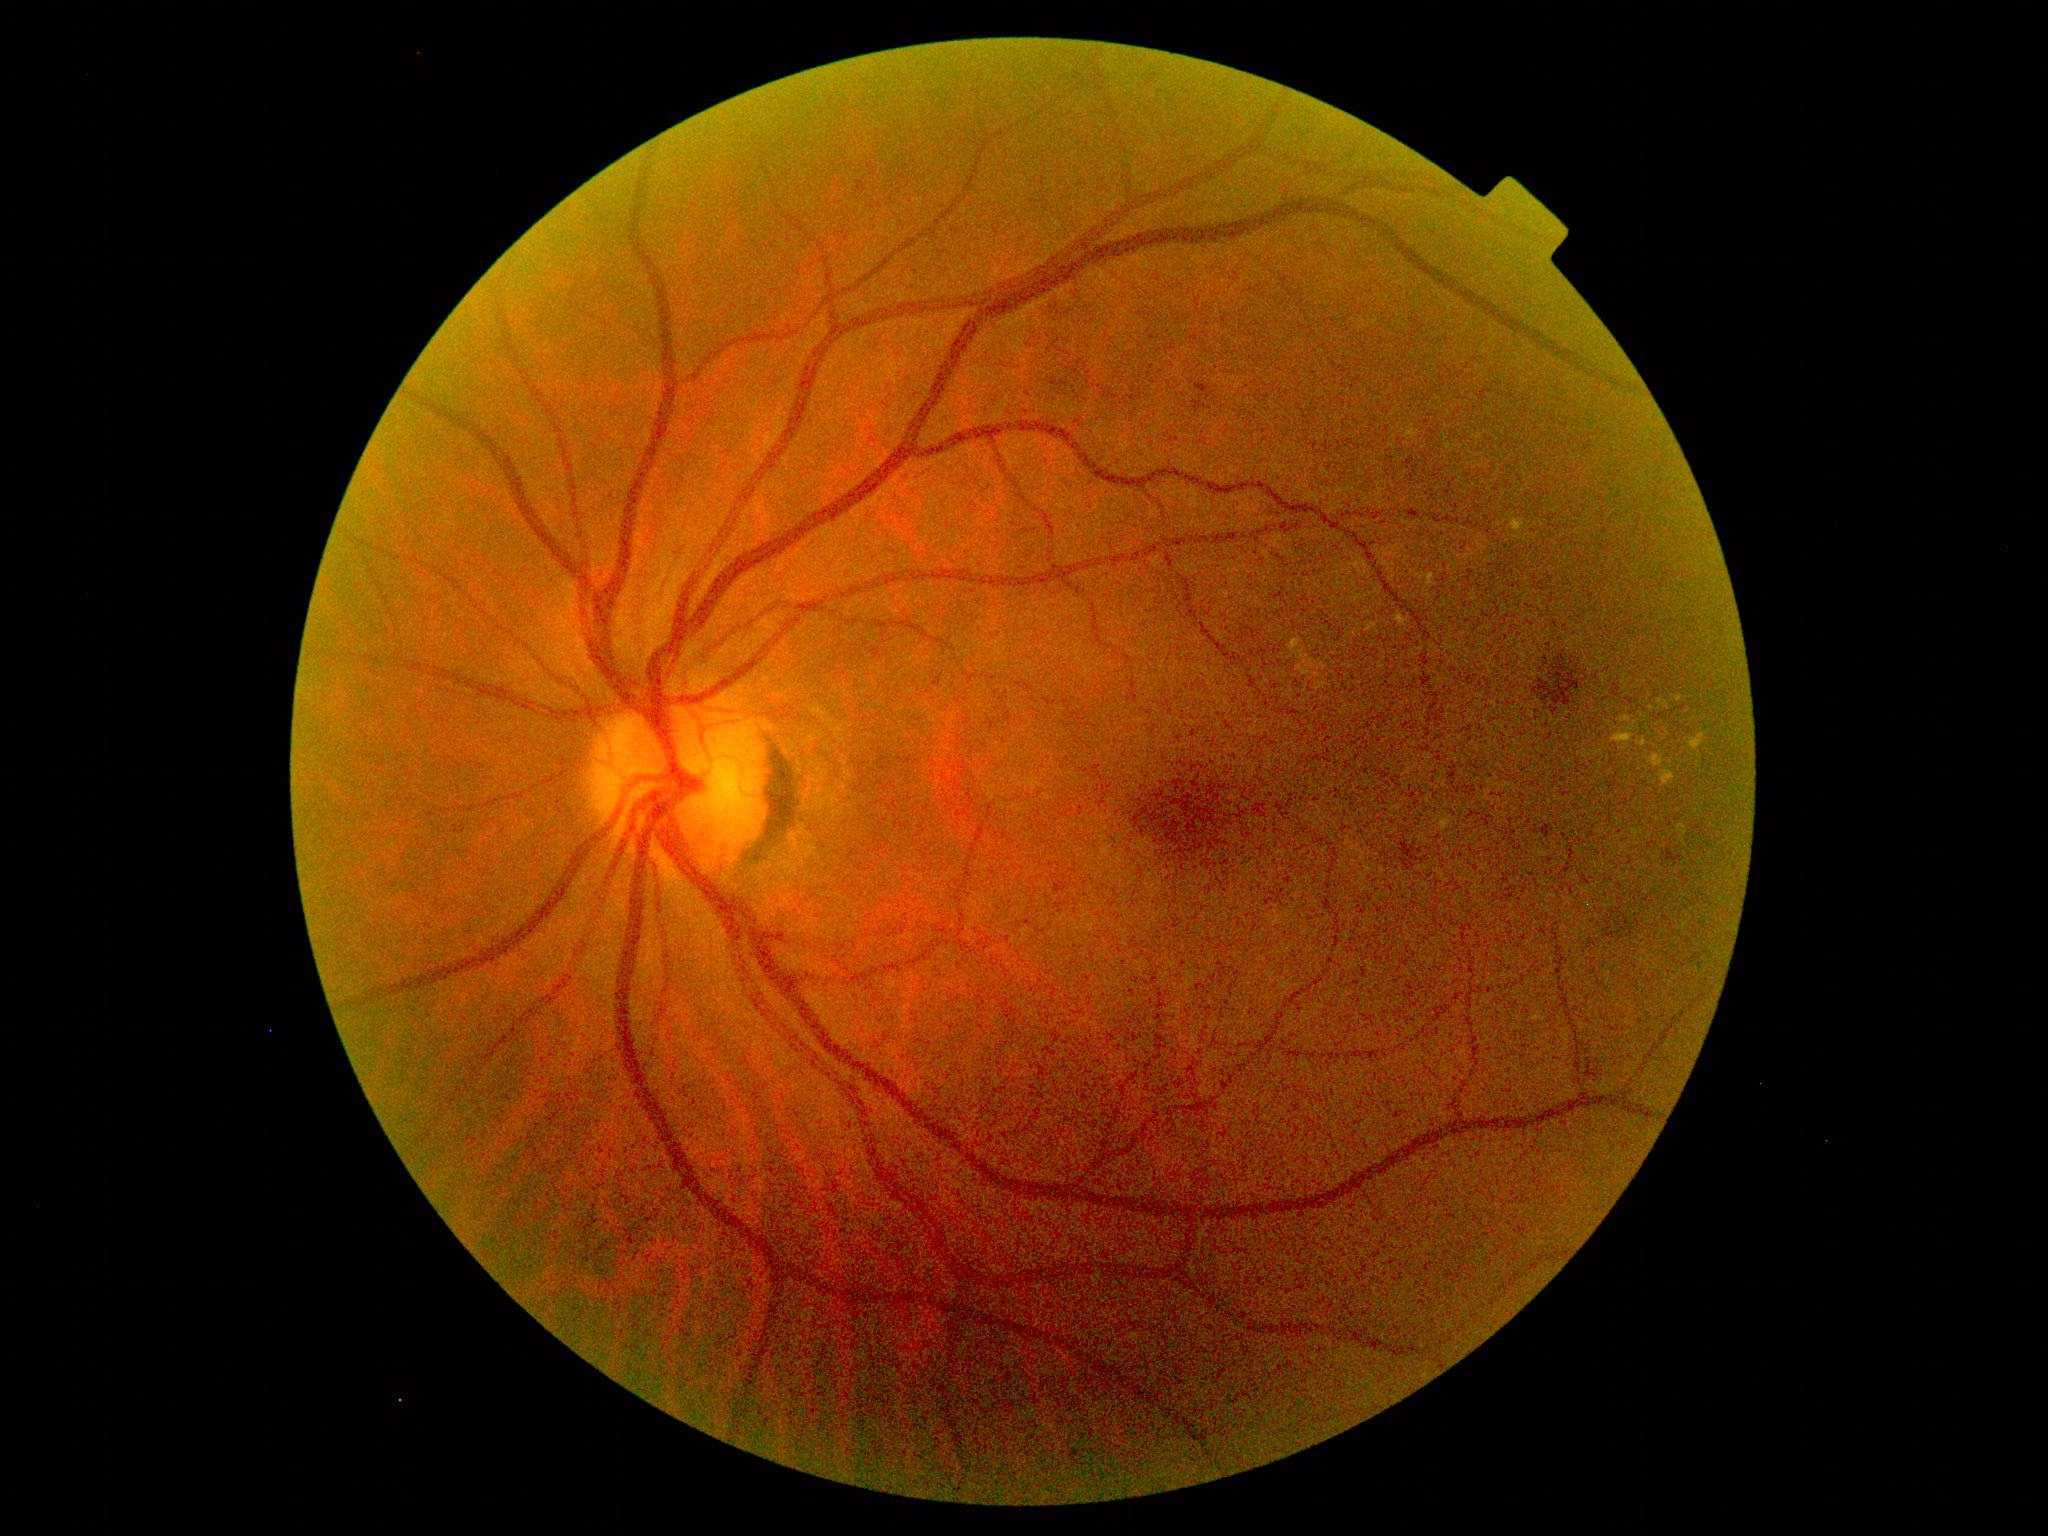 DR: moderate non-proliferative diabetic retinopathy (grade 2).